NIDEK AFC-230 fundus camera. FOV: 45 degrees. 848 by 848 pixels. Color fundus image: 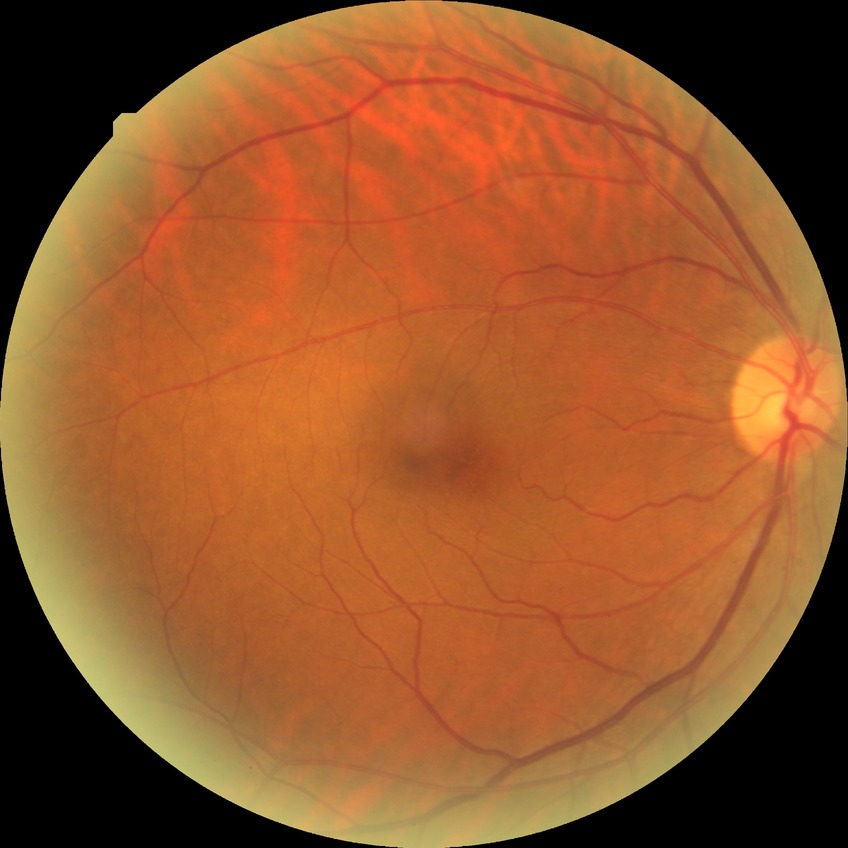
Diabetic retinopathy (DR): no diabetic retinopathy (NDR).